Camera: Natus RetCam Envision (130° FOV) · RetCam wide-field infant fundus image — 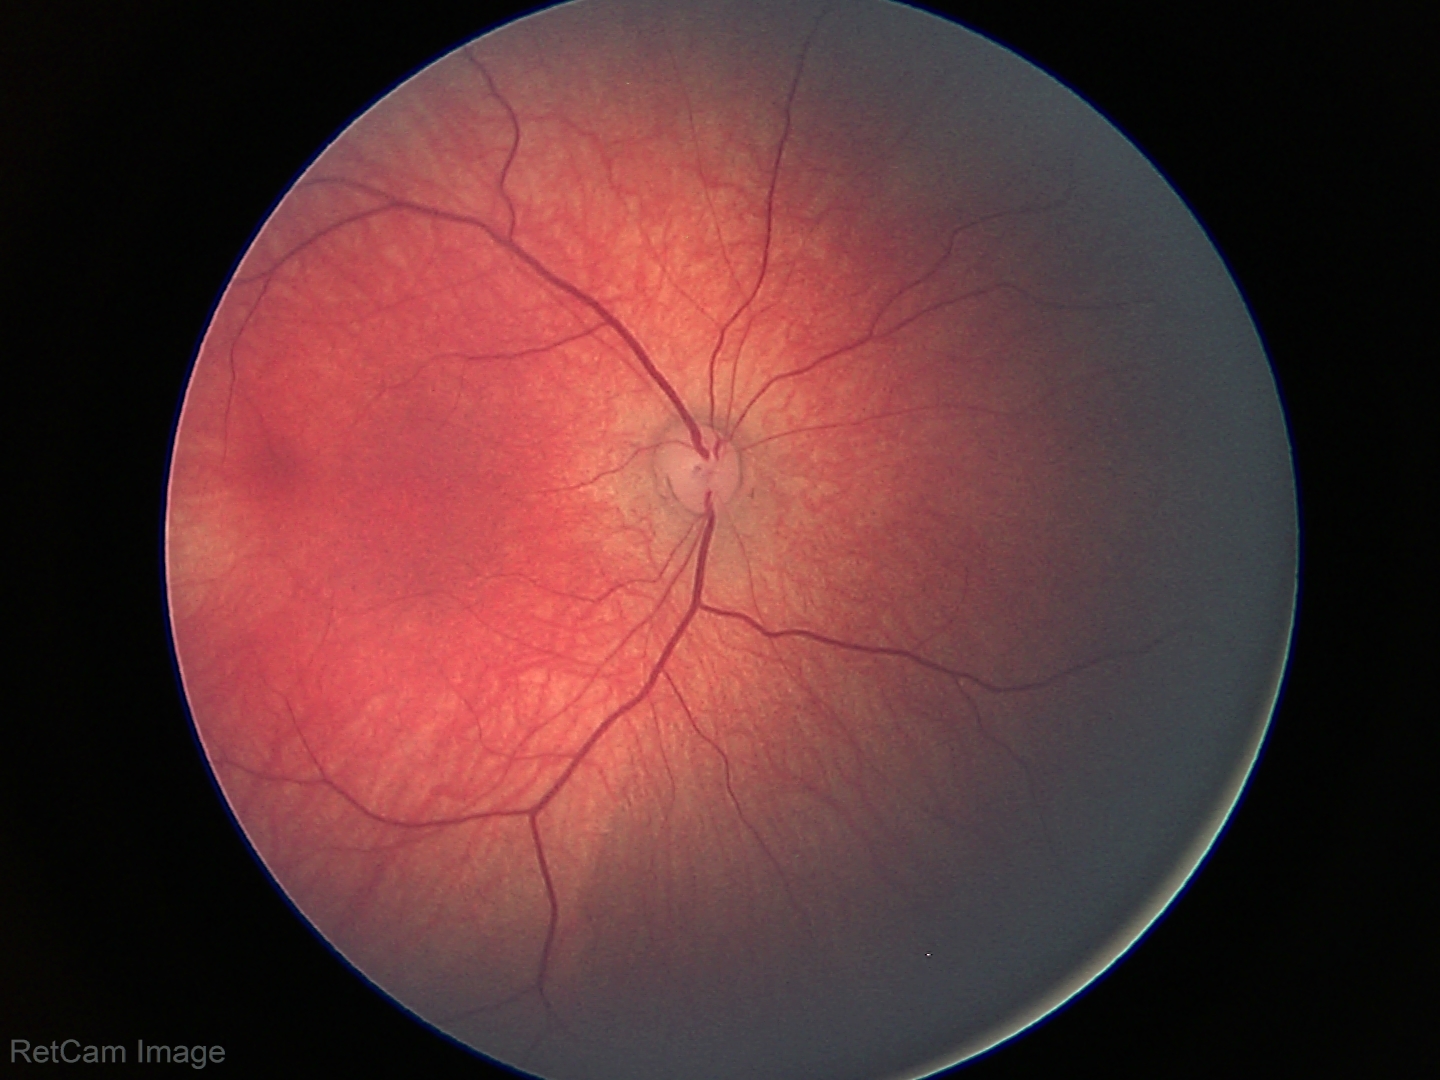 Normal screening examination.